CFP — 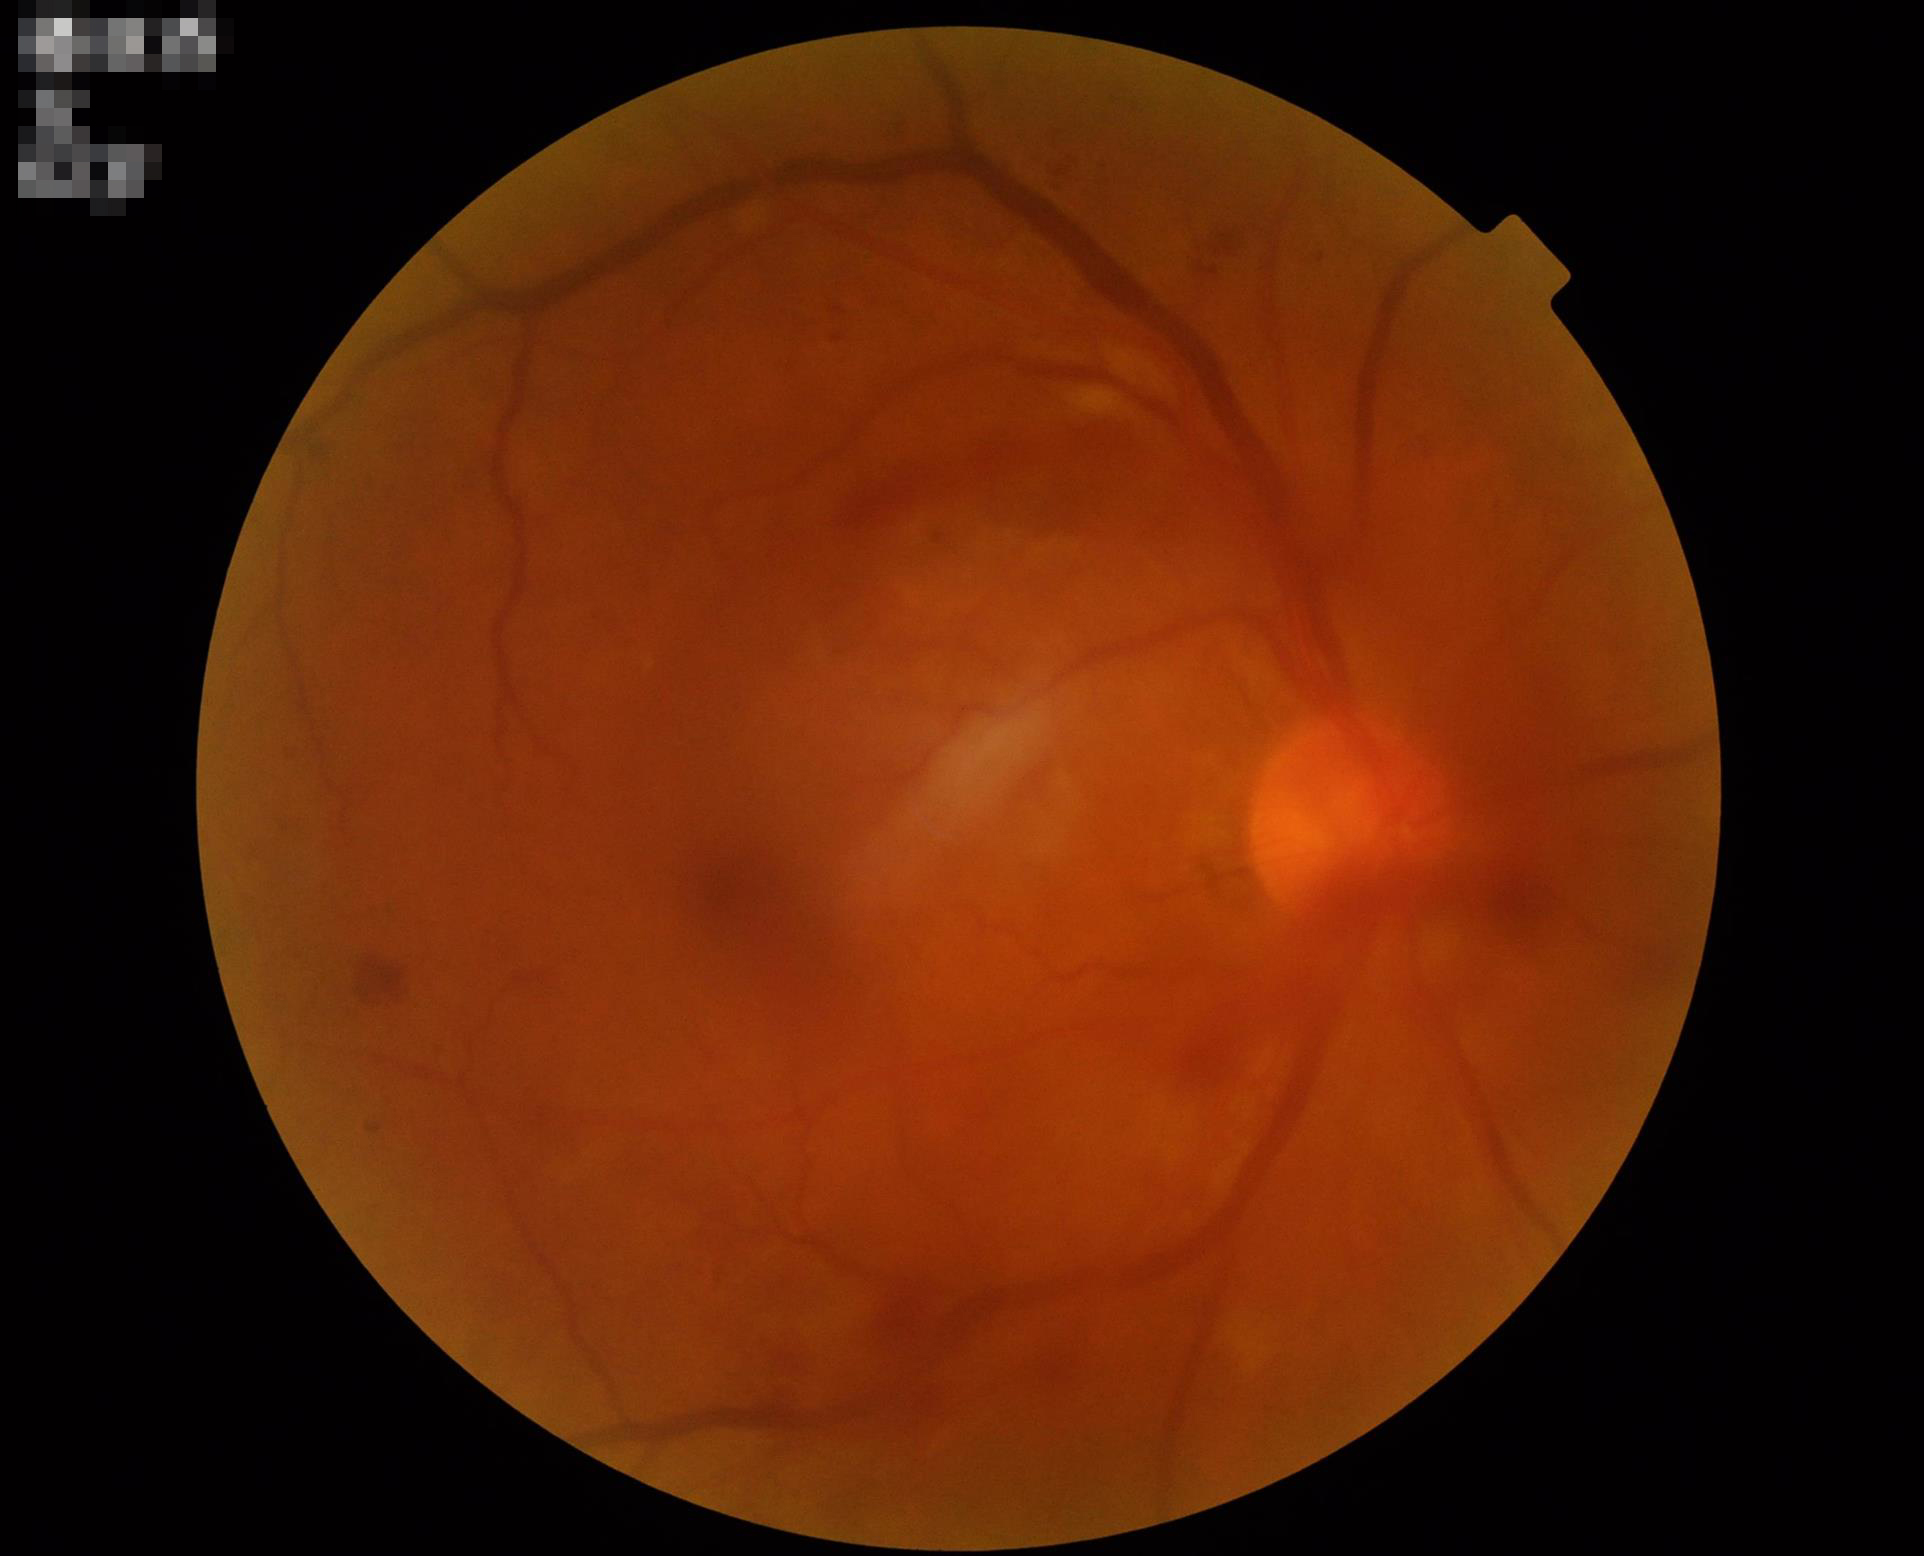 Good dynamic range.
Noticeable blur in the optic disc, vessels, or background.
Image quality is inadequate for diagnostic use.